CFP · 1932 x 1932 pixels · FOV: 45 degrees:
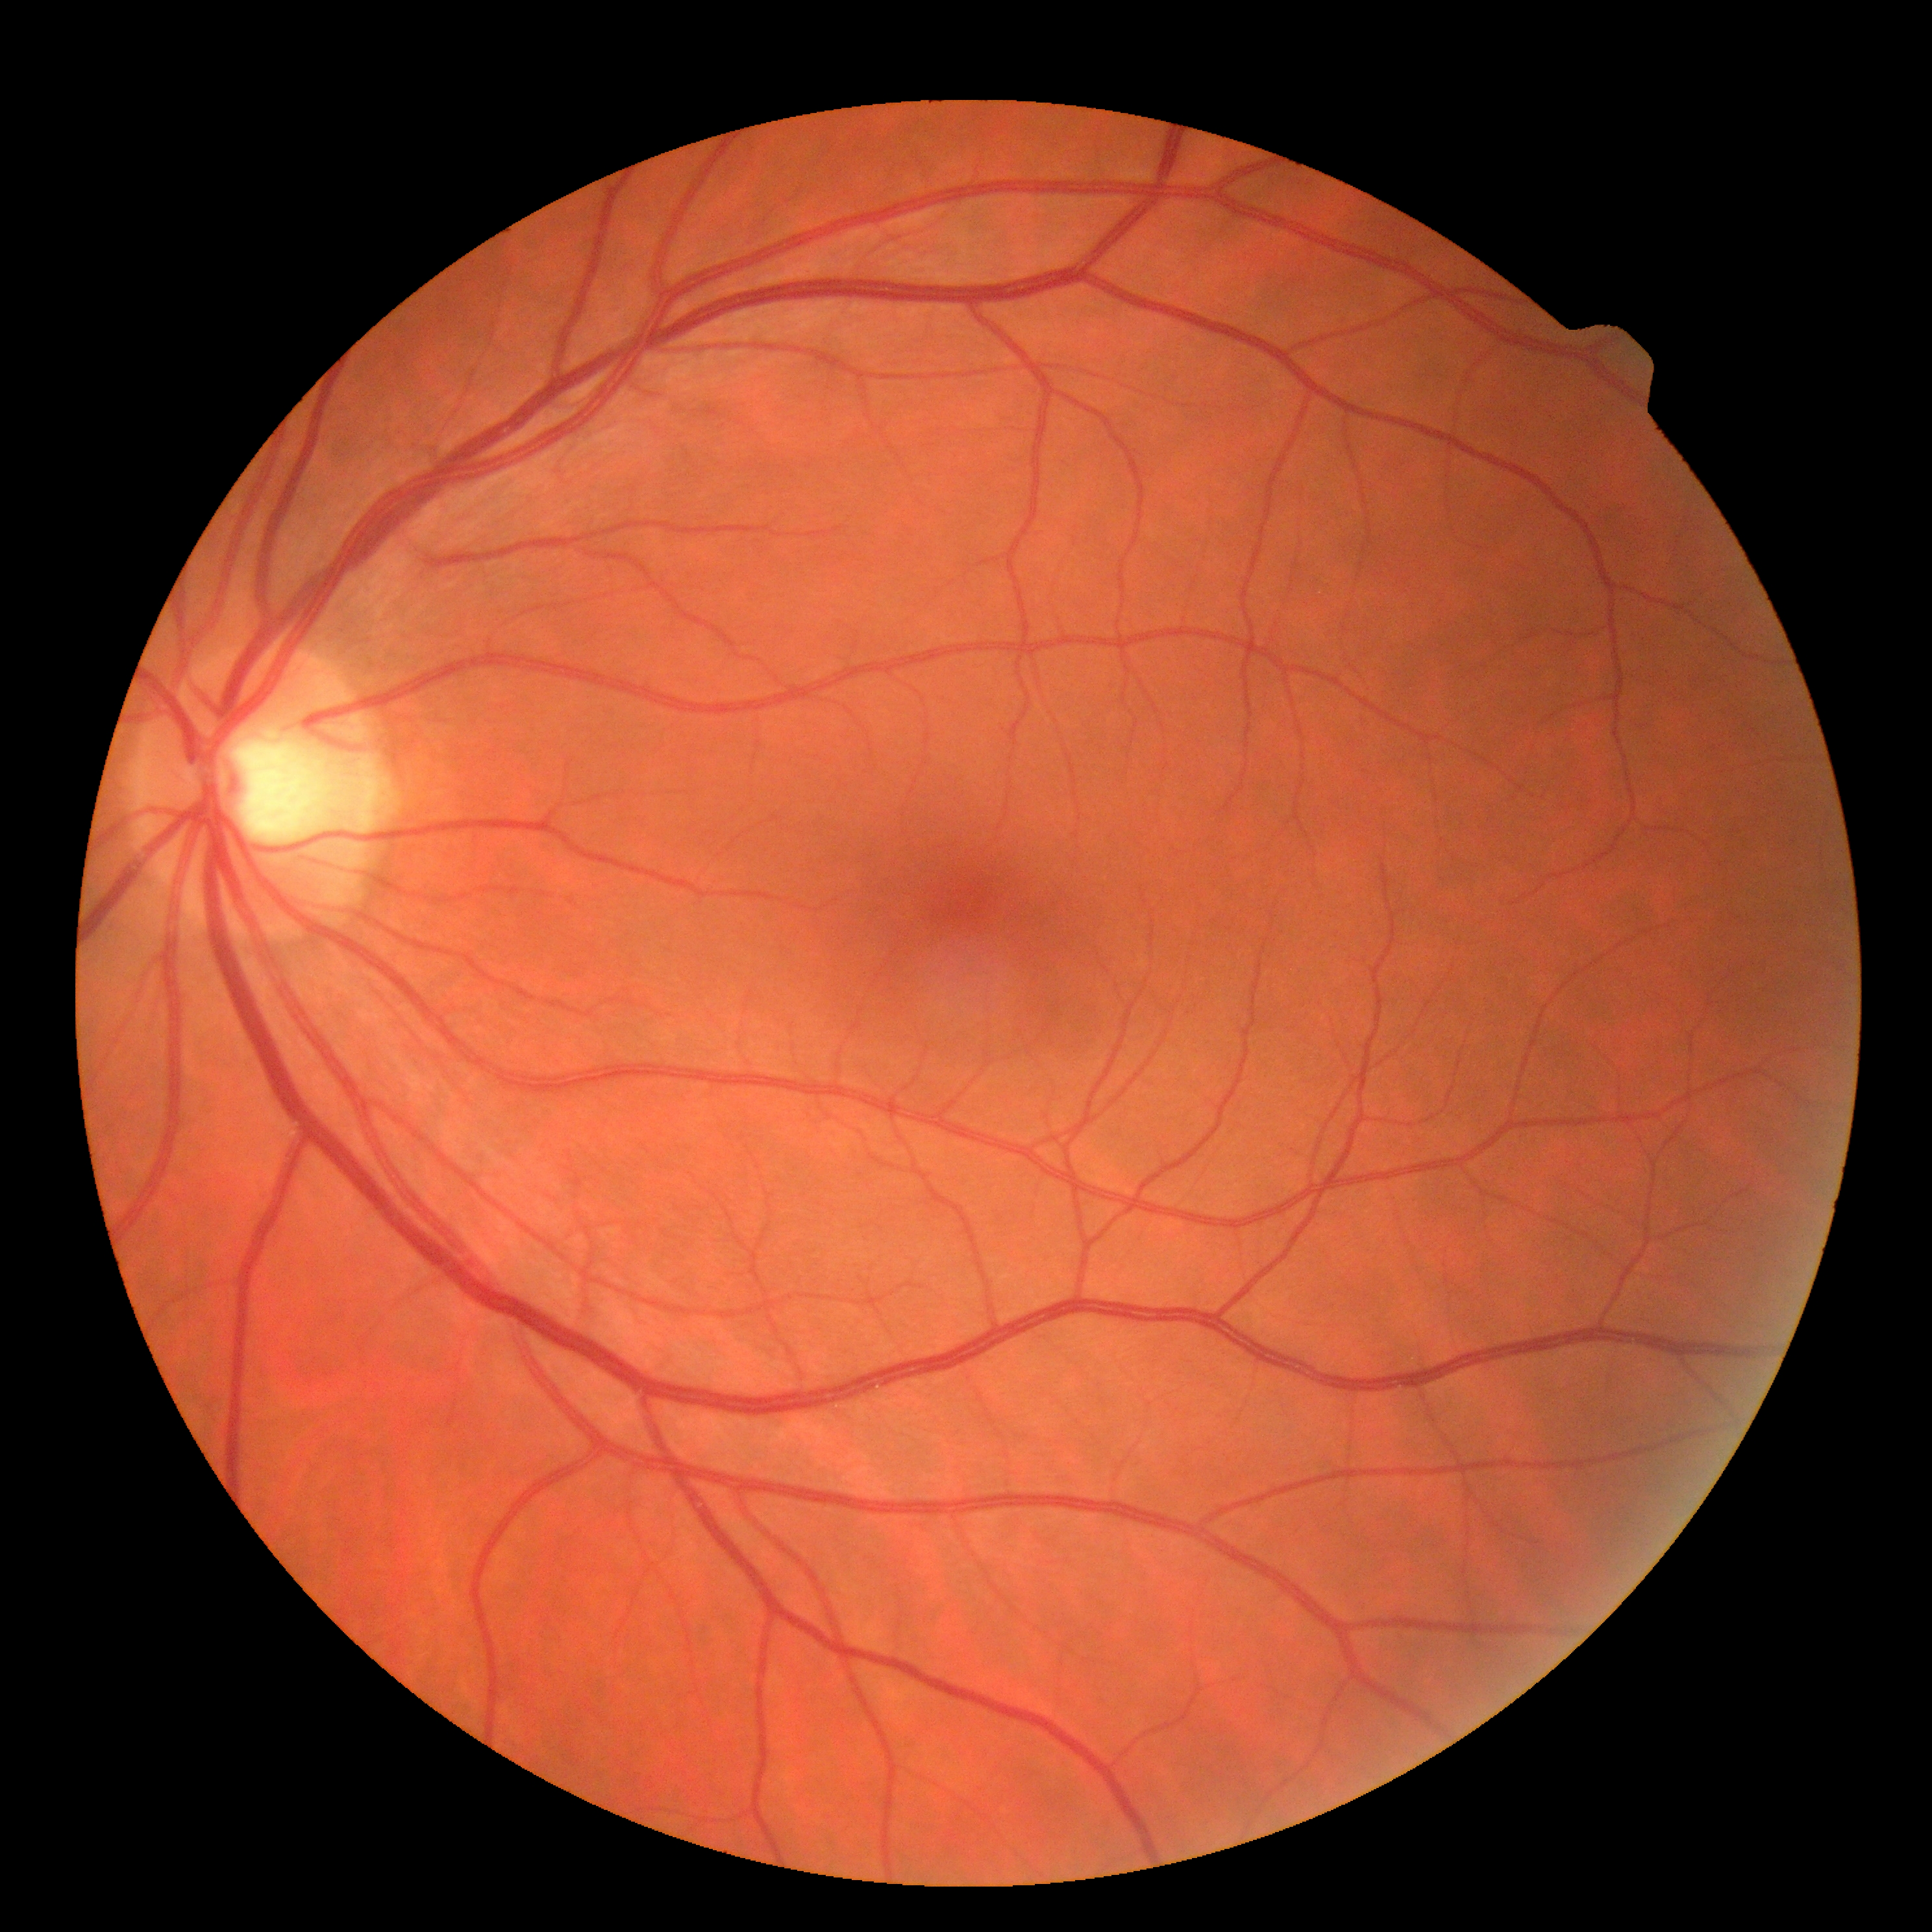

retinopathy: grade 0.